2212x1659.
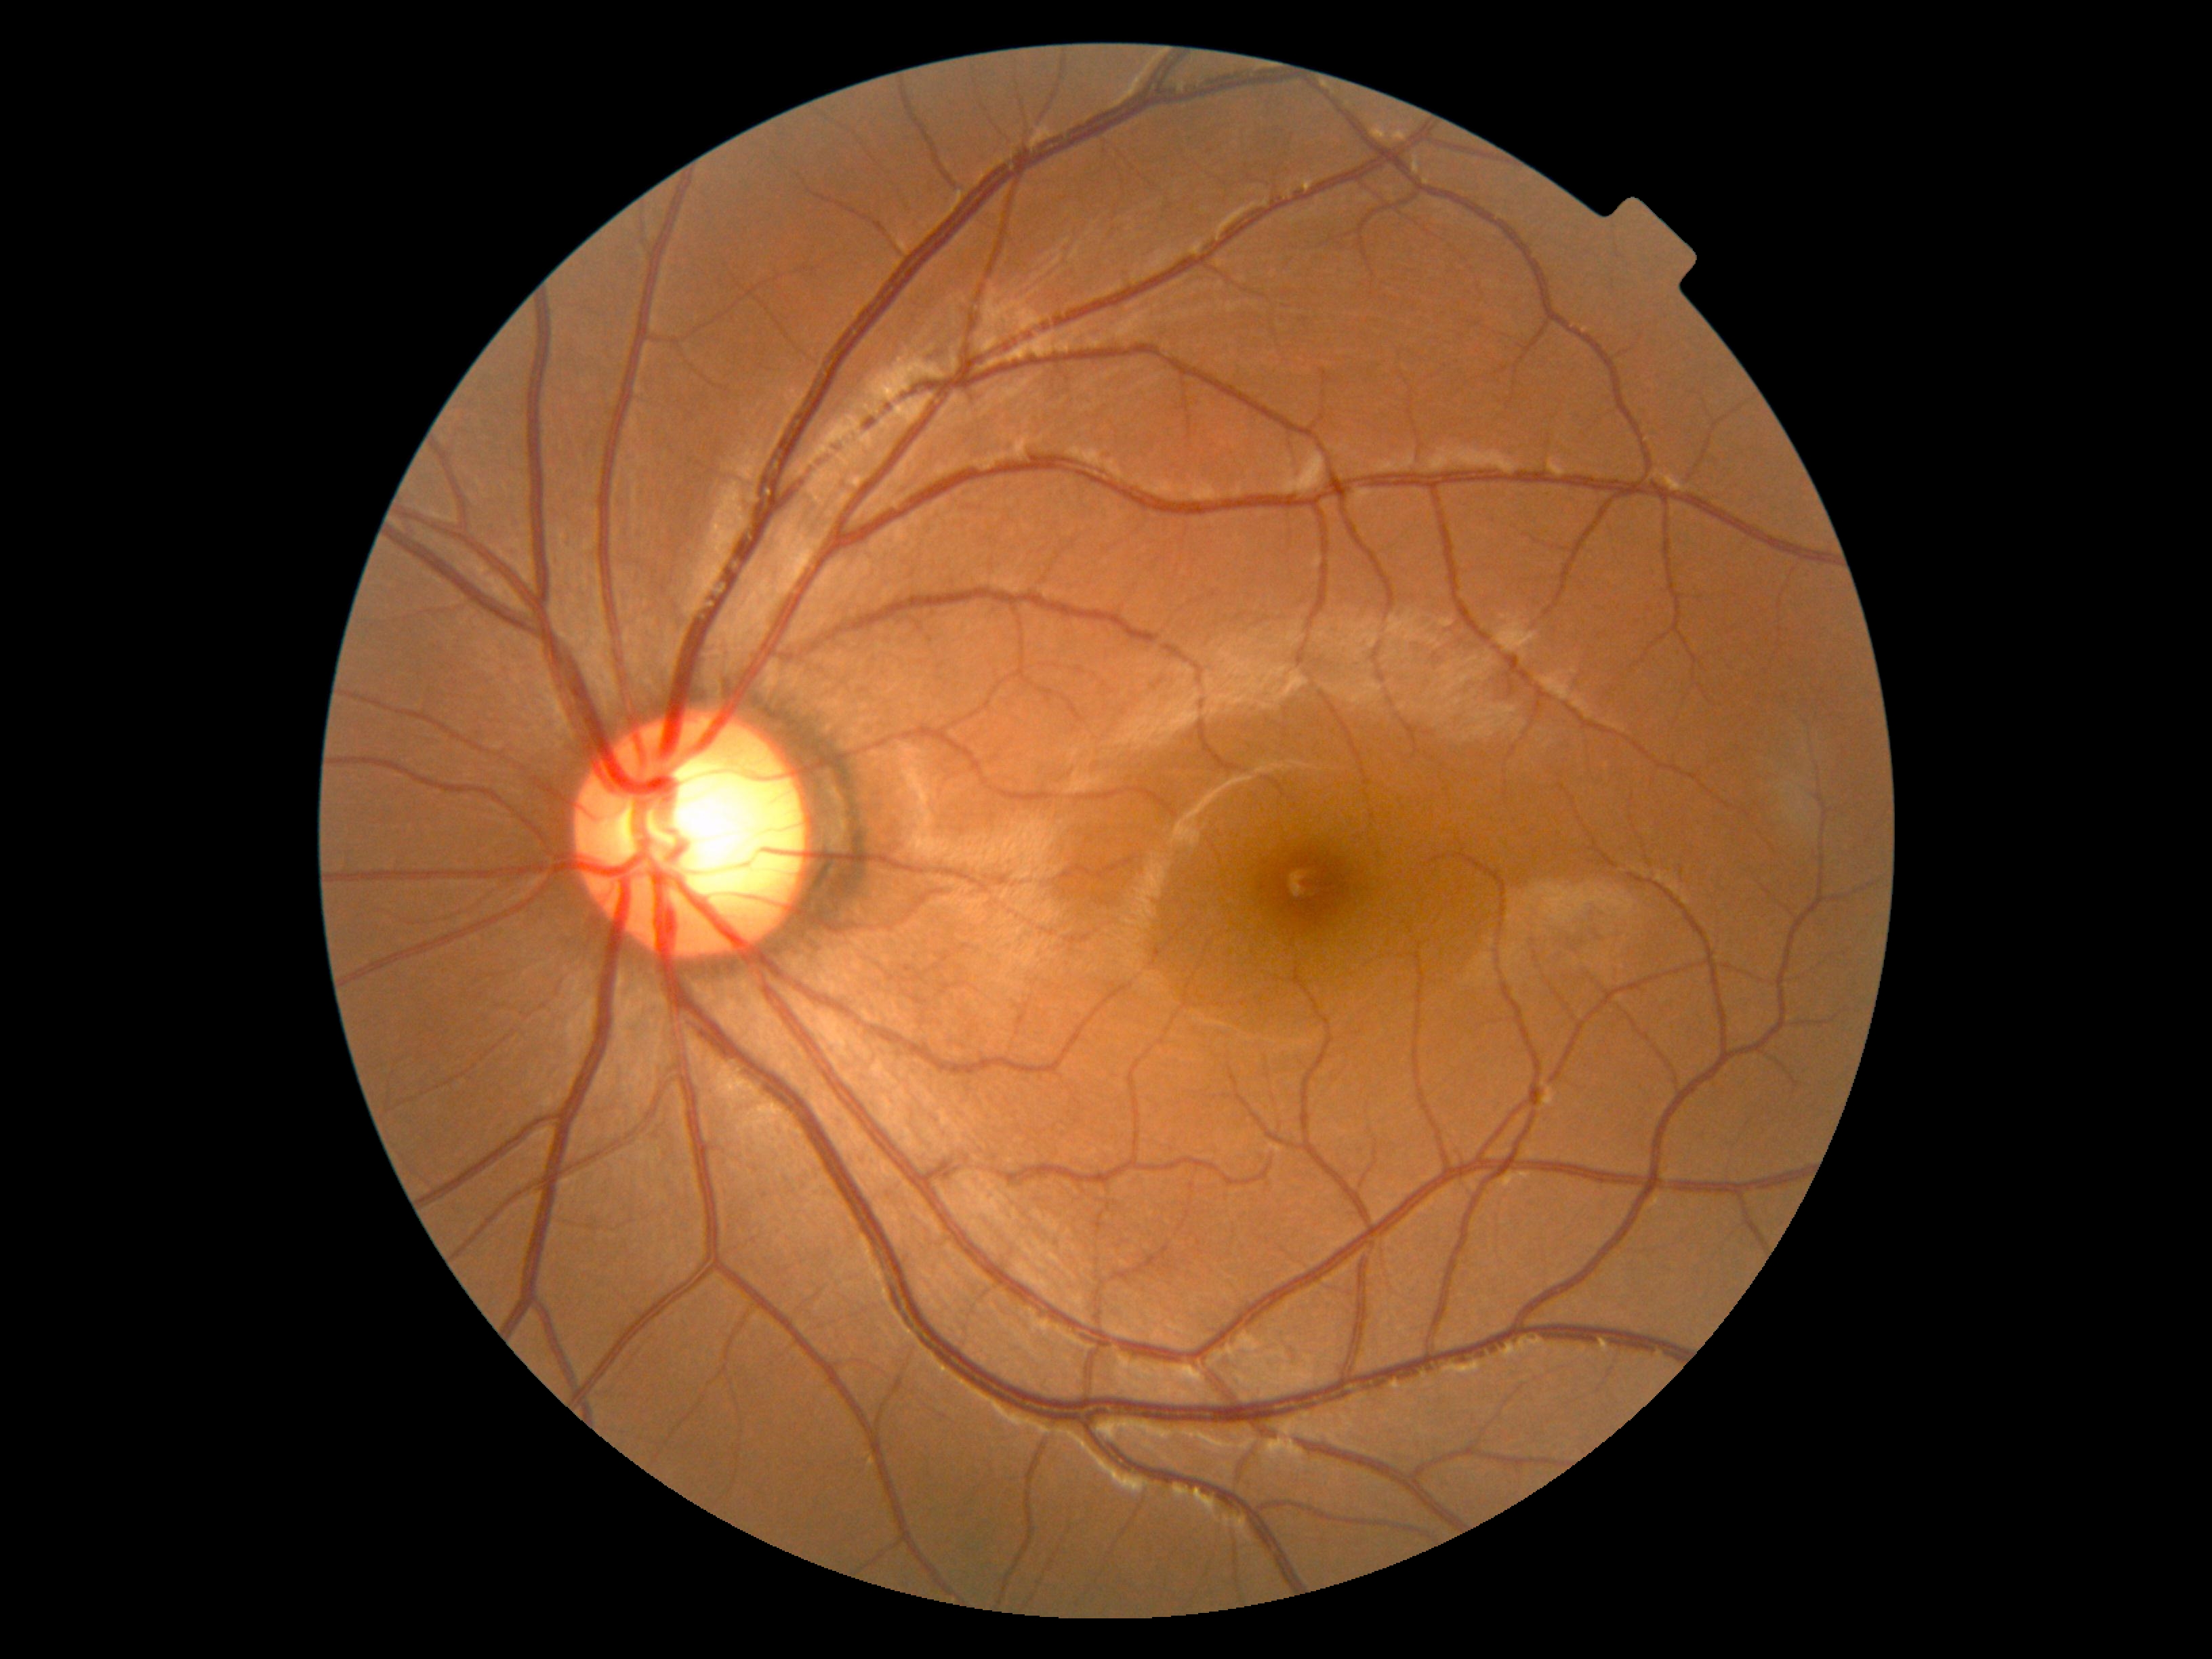 Diabetic retinopathy (DR) is 0.